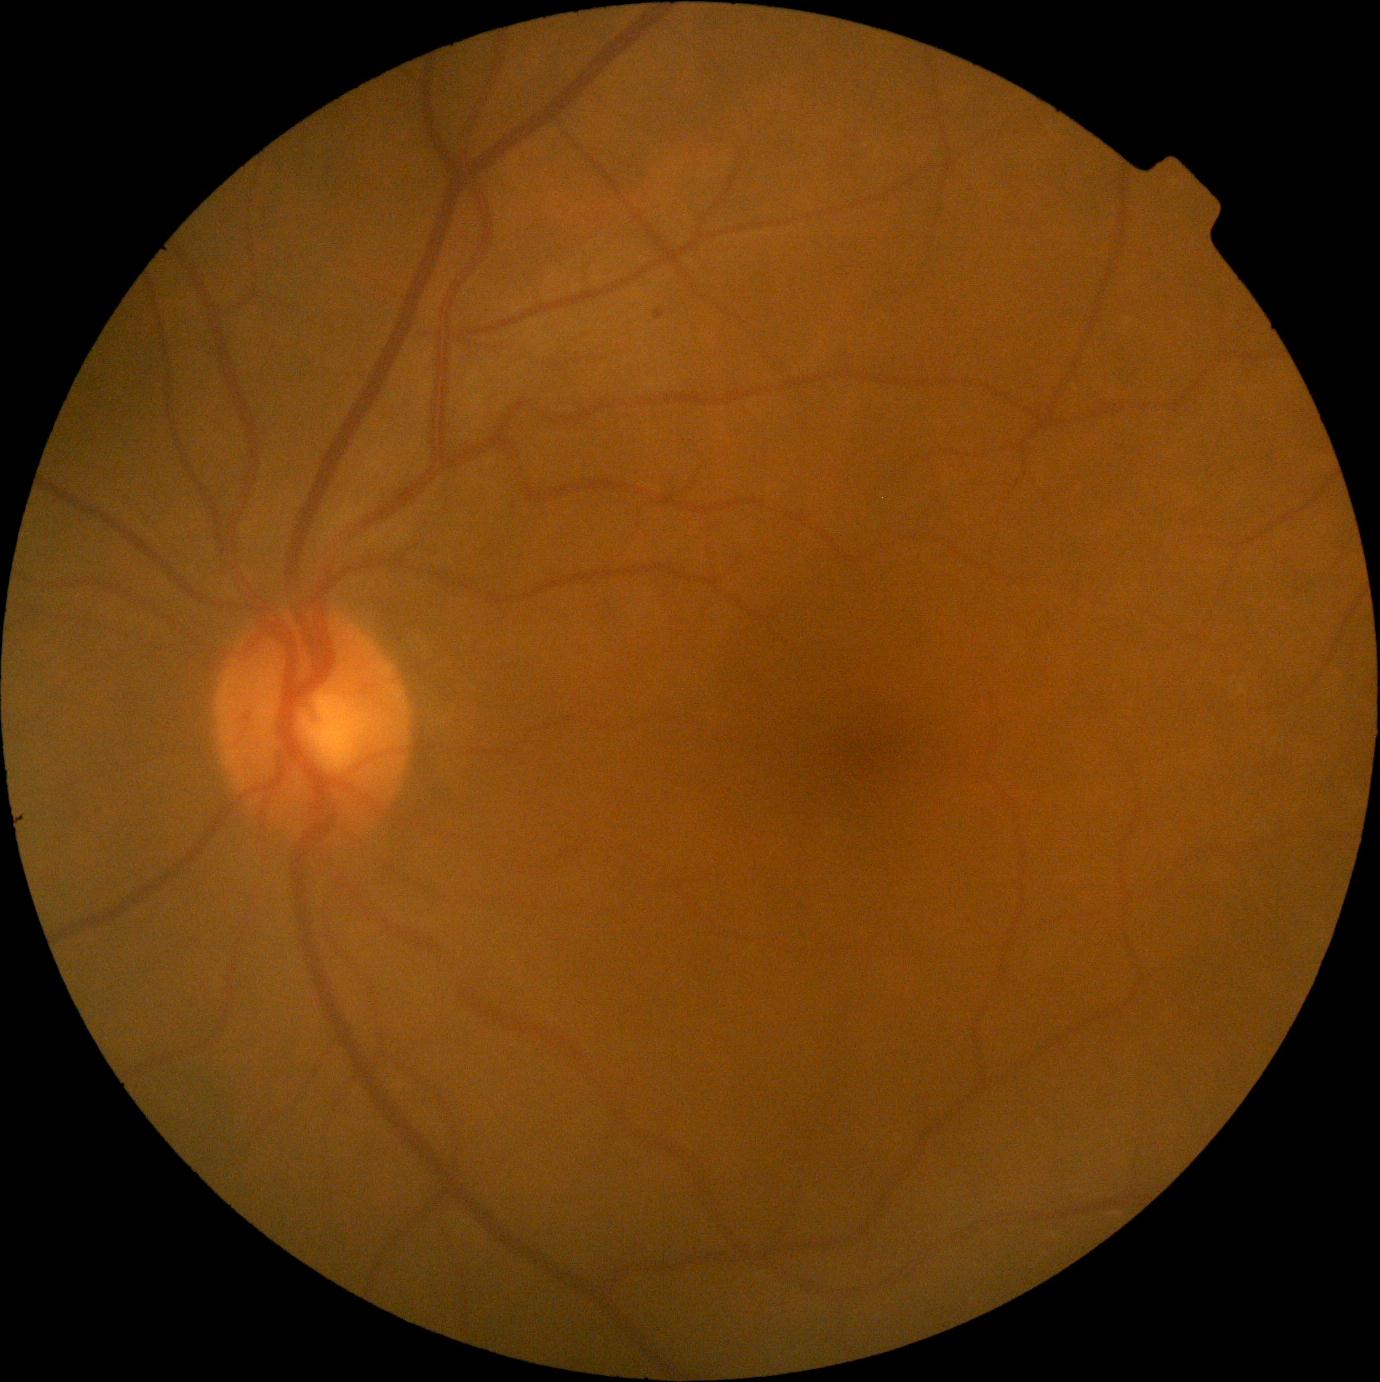 Diabetic retinopathy (DR) is grade 1 (mild NPDR)
soft exudates (SEs) = none
microaneurysms (MAs) = {"left": 654, "top": 310, "right": 666, "bottom": 320}
hard exudates (EXs) = none
hemorrhages (HEs) = none